45-degree field of view
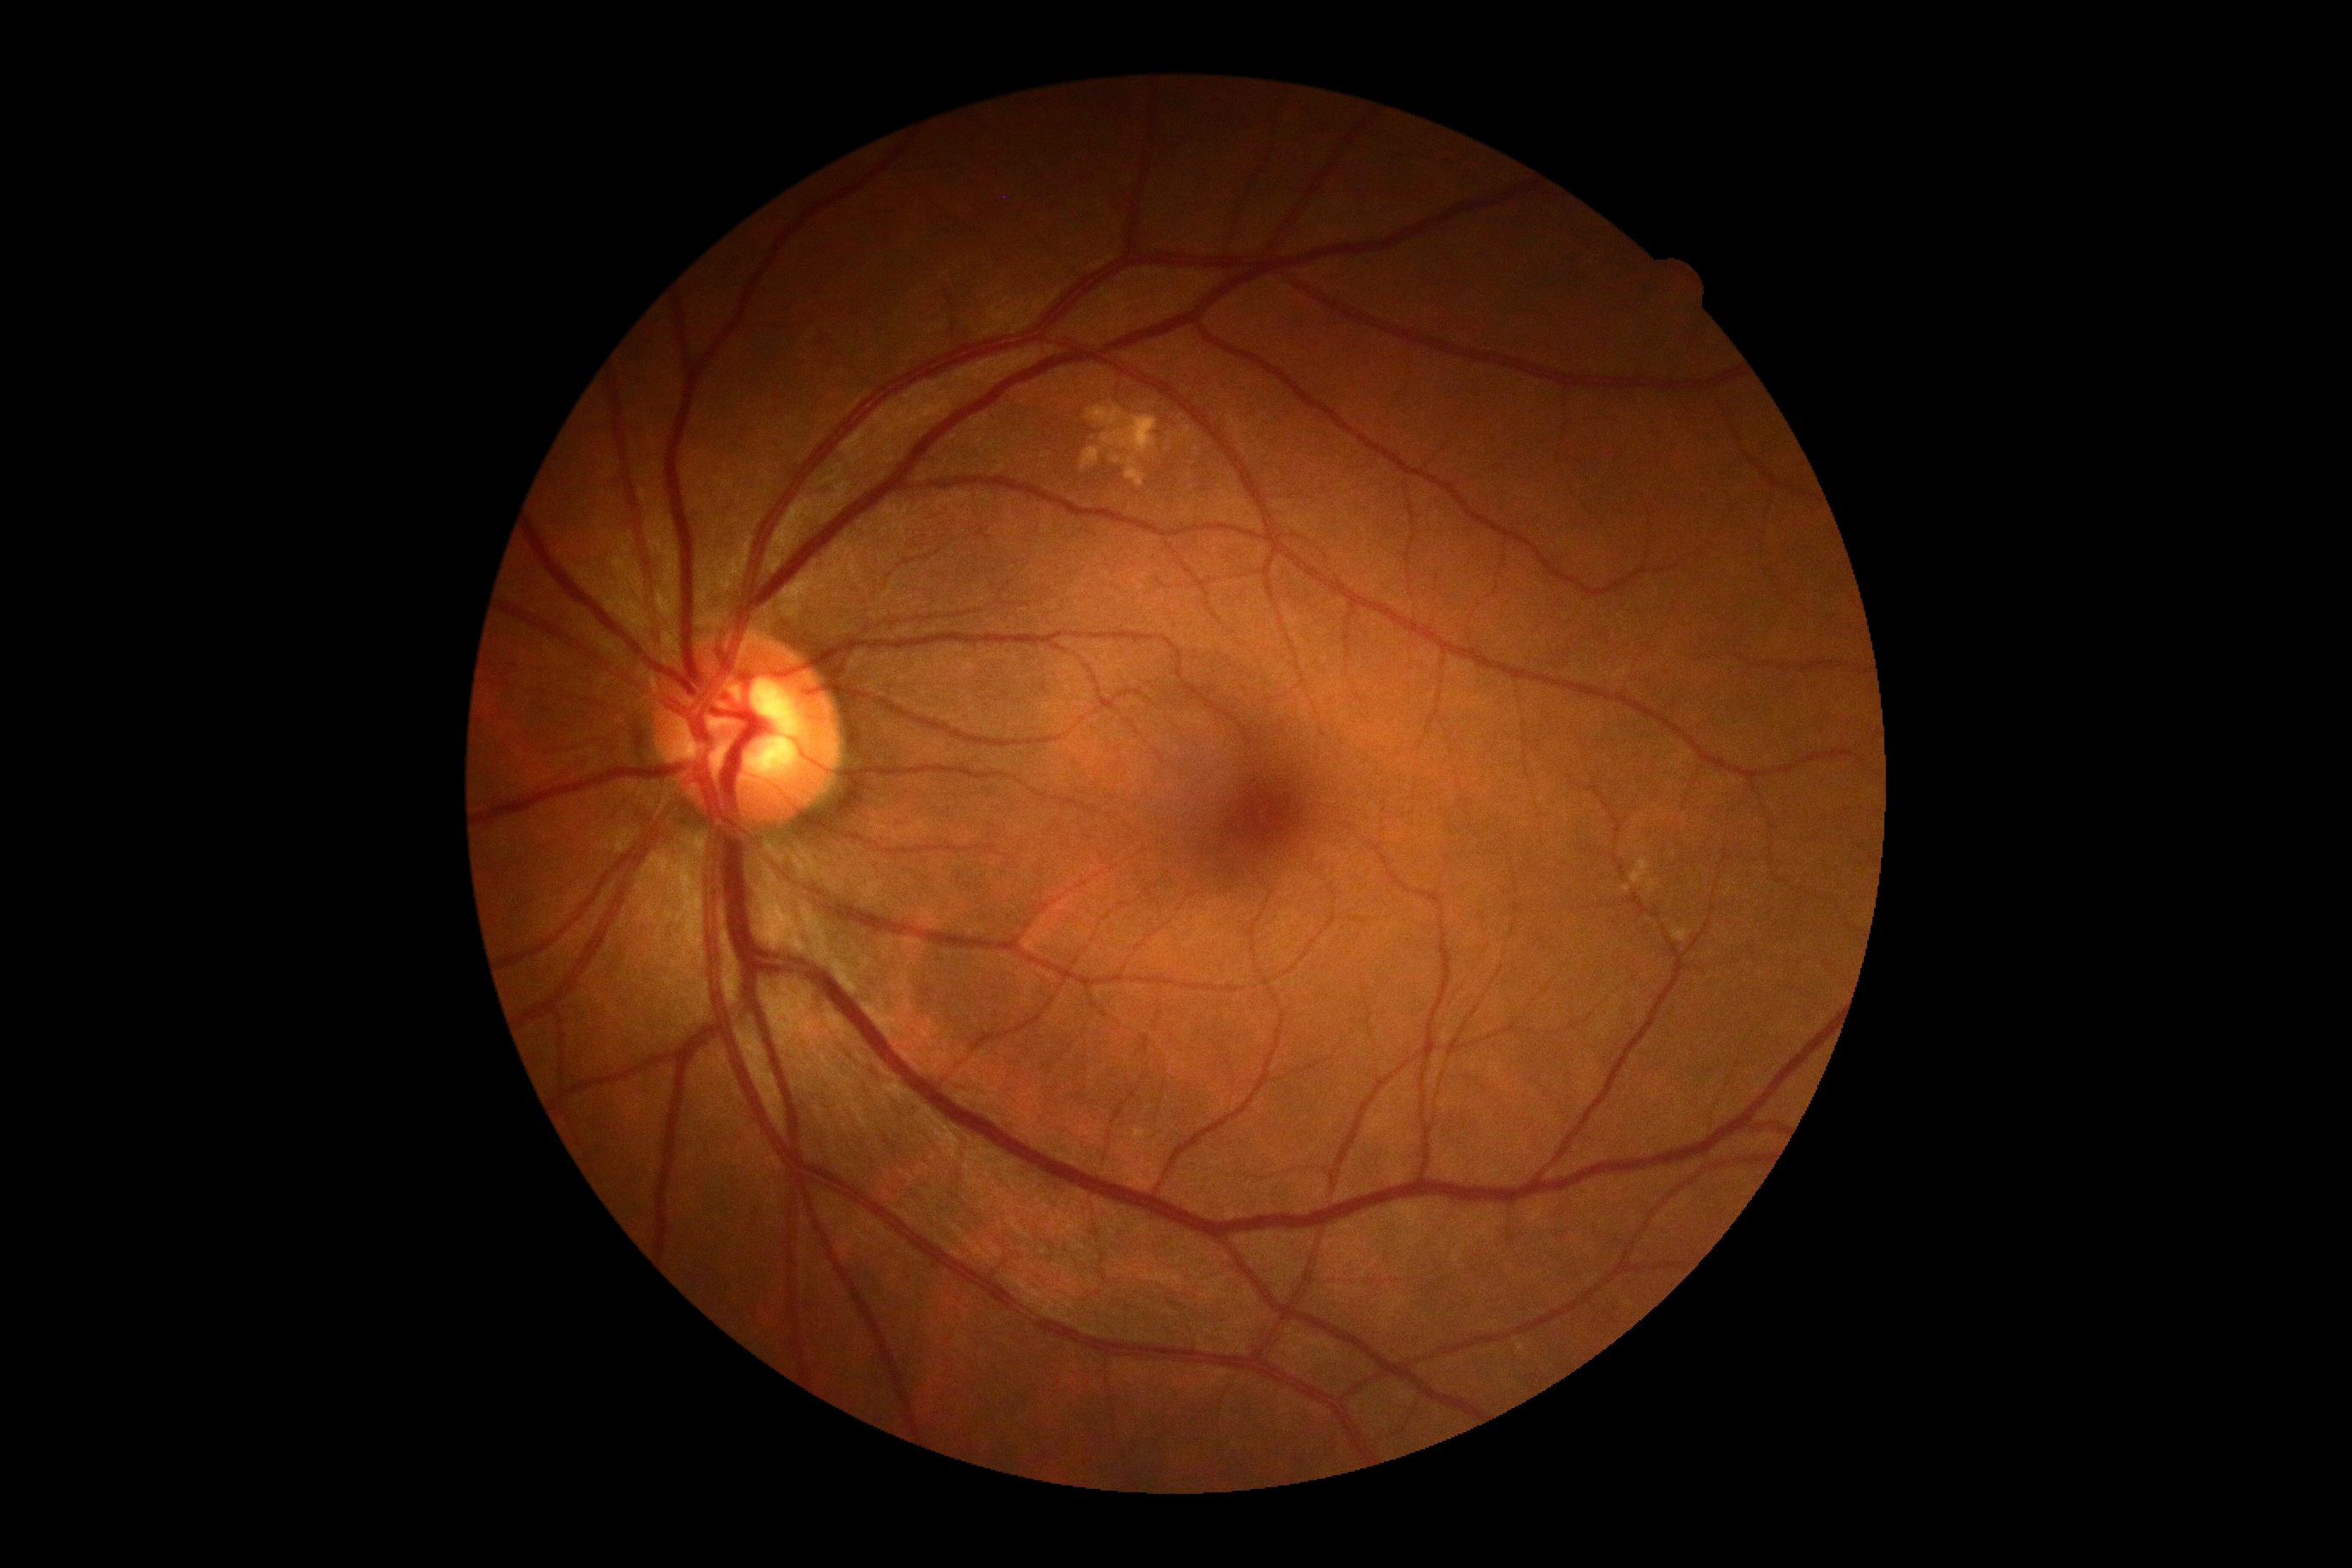
Diabetic retinopathy severity: grade 0 (no apparent retinopathy).
No DR findings.